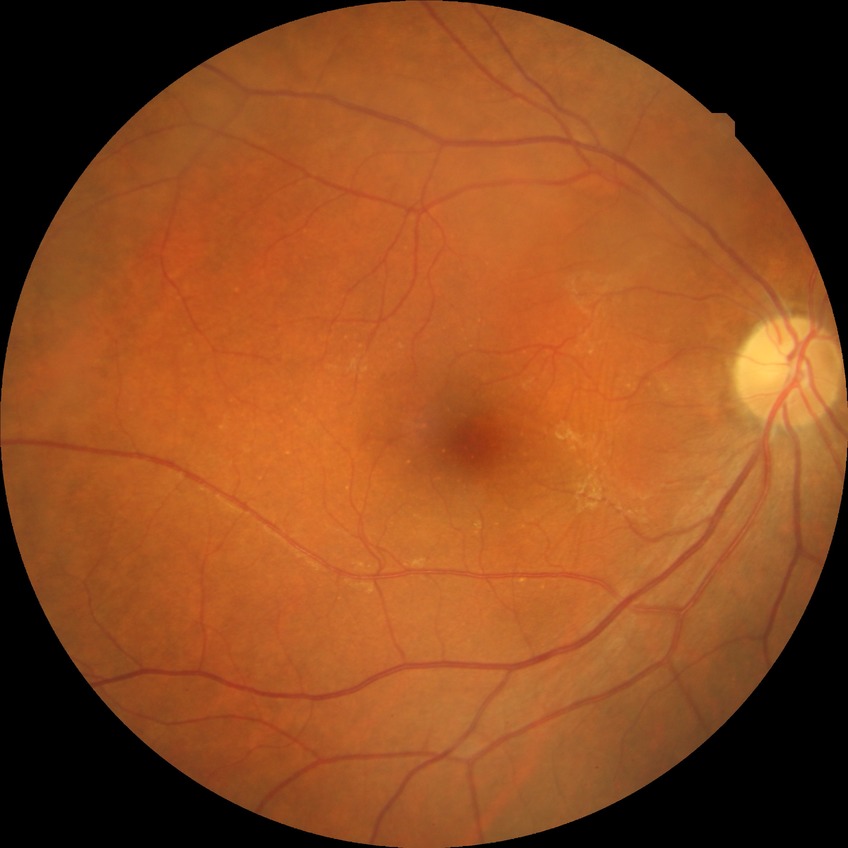

diabetic retinopathy (DR): NDR (no diabetic retinopathy).